Wide-field fundus photograph from neonatal ROP screening; 1440x1080: 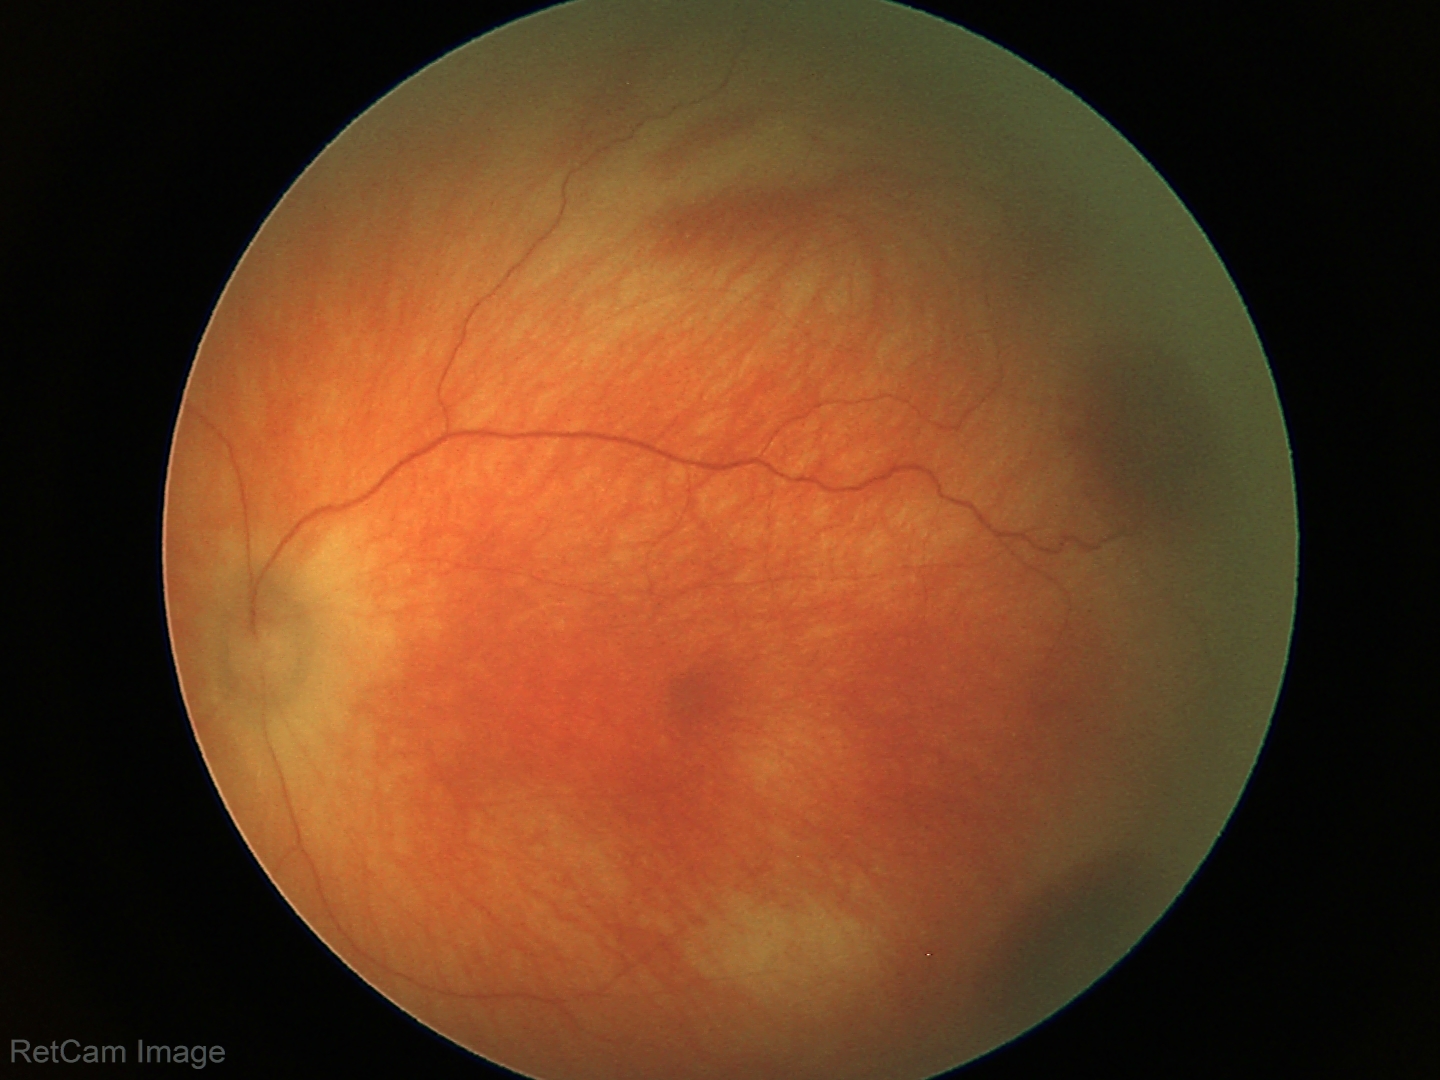 Screening series with retinal hemorrhages.